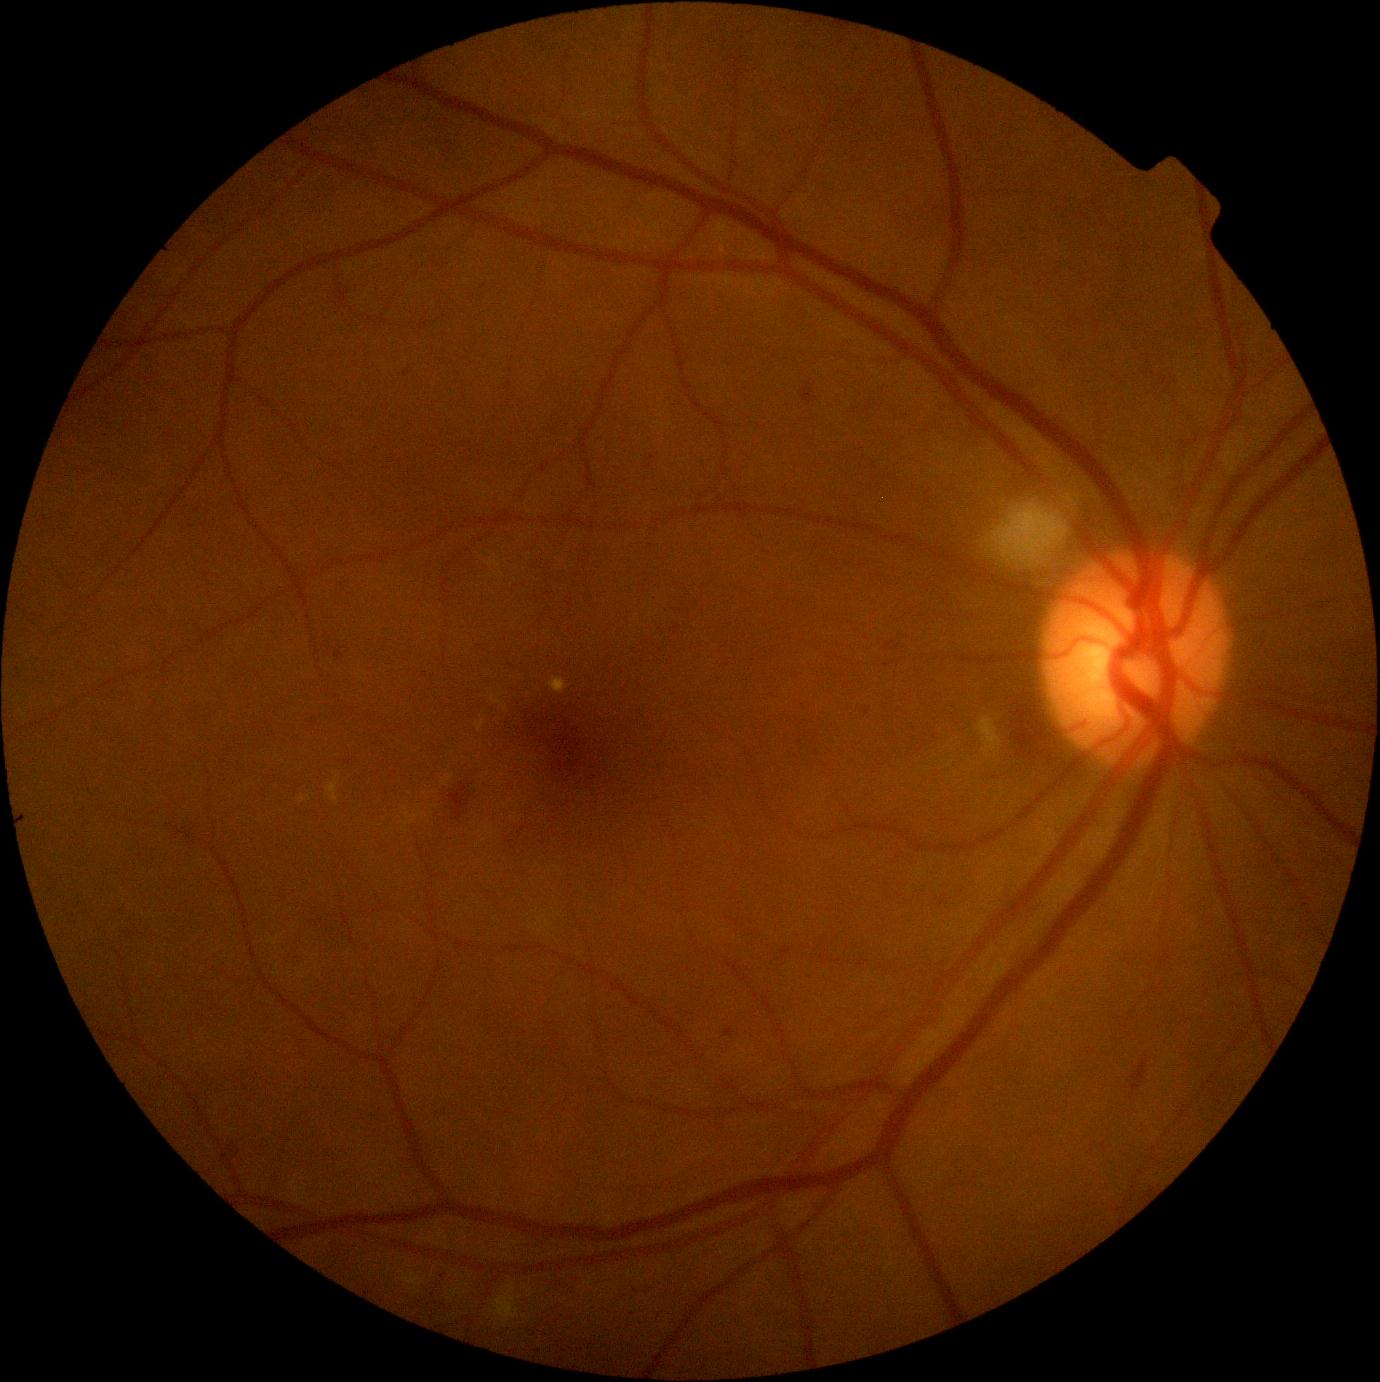
Diabetic retinopathy: moderate NPDR (grade 2).